Infant wide-field retinal image; 1440 x 1080 pixels:
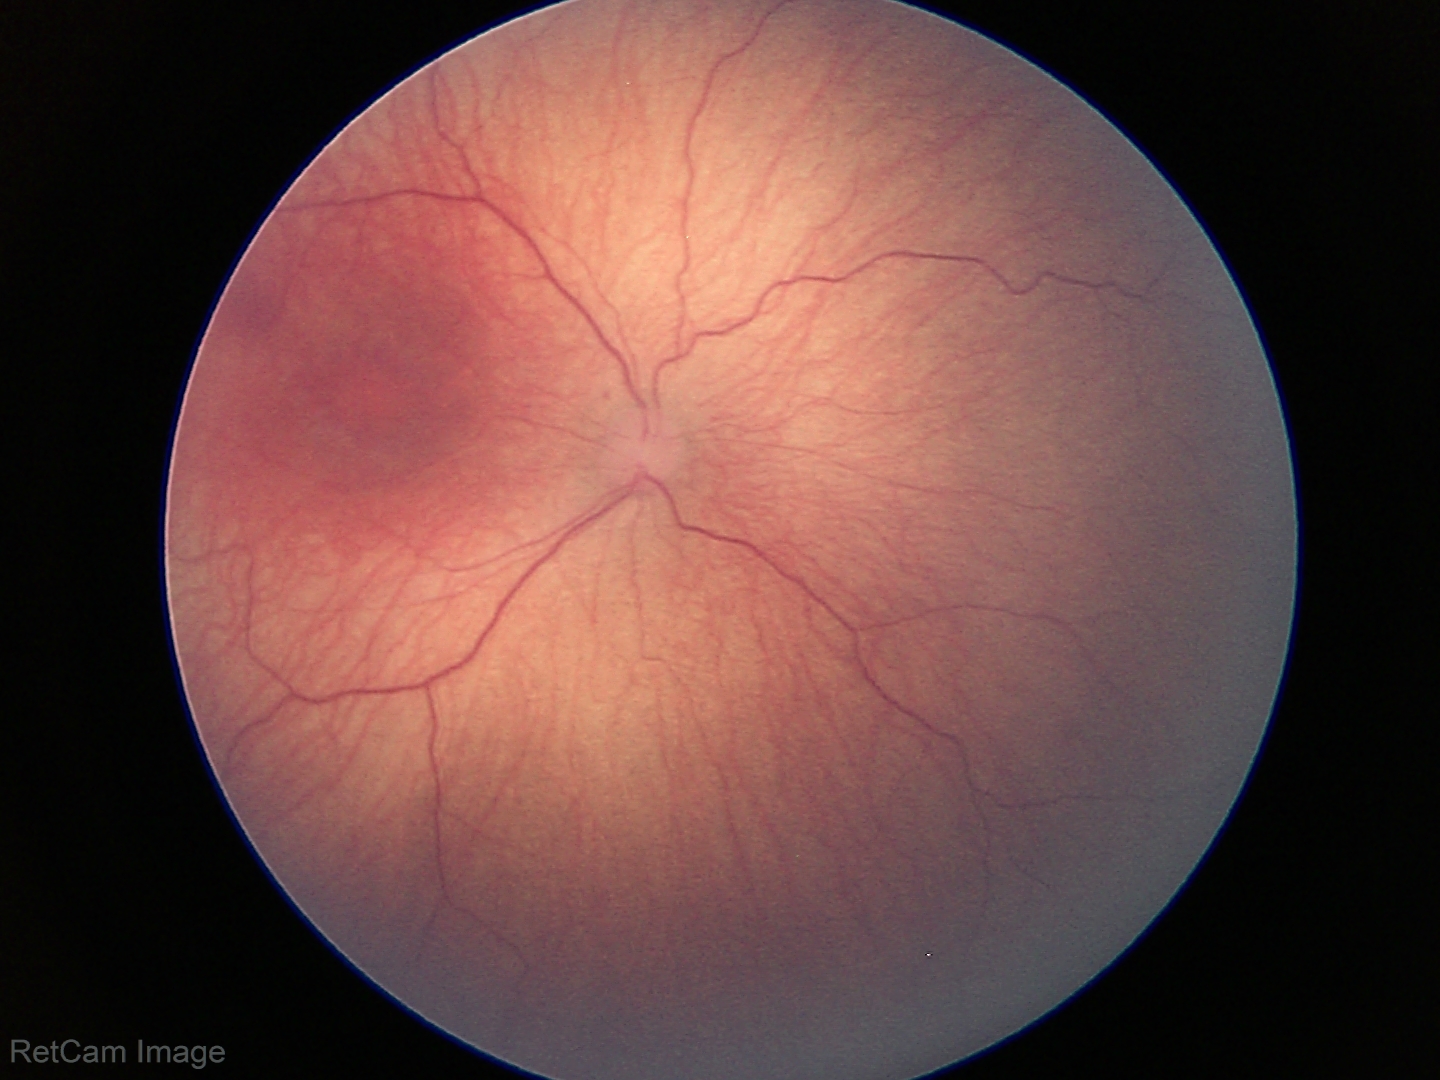 Screening diagnosis: ROP stage 1; plus form: absent.